848 x 848 pixels — 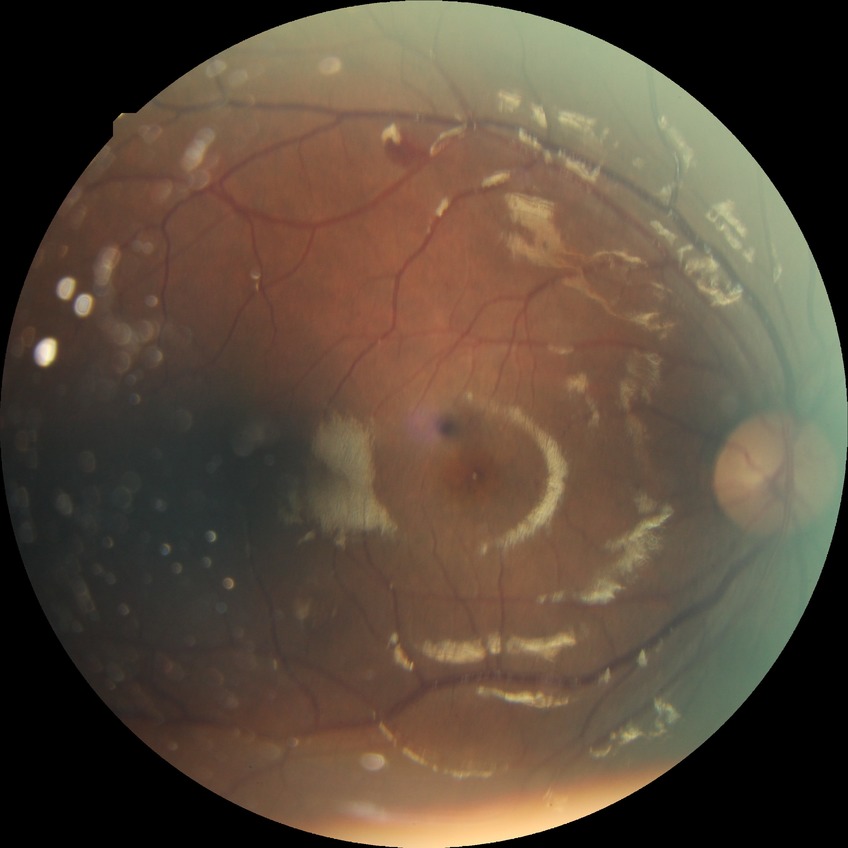

diabetic retinopathy (DR) = SDR (simple diabetic retinopathy); DR class = non-proliferative diabetic retinopathy.